Color fundus image · 45° FOV.
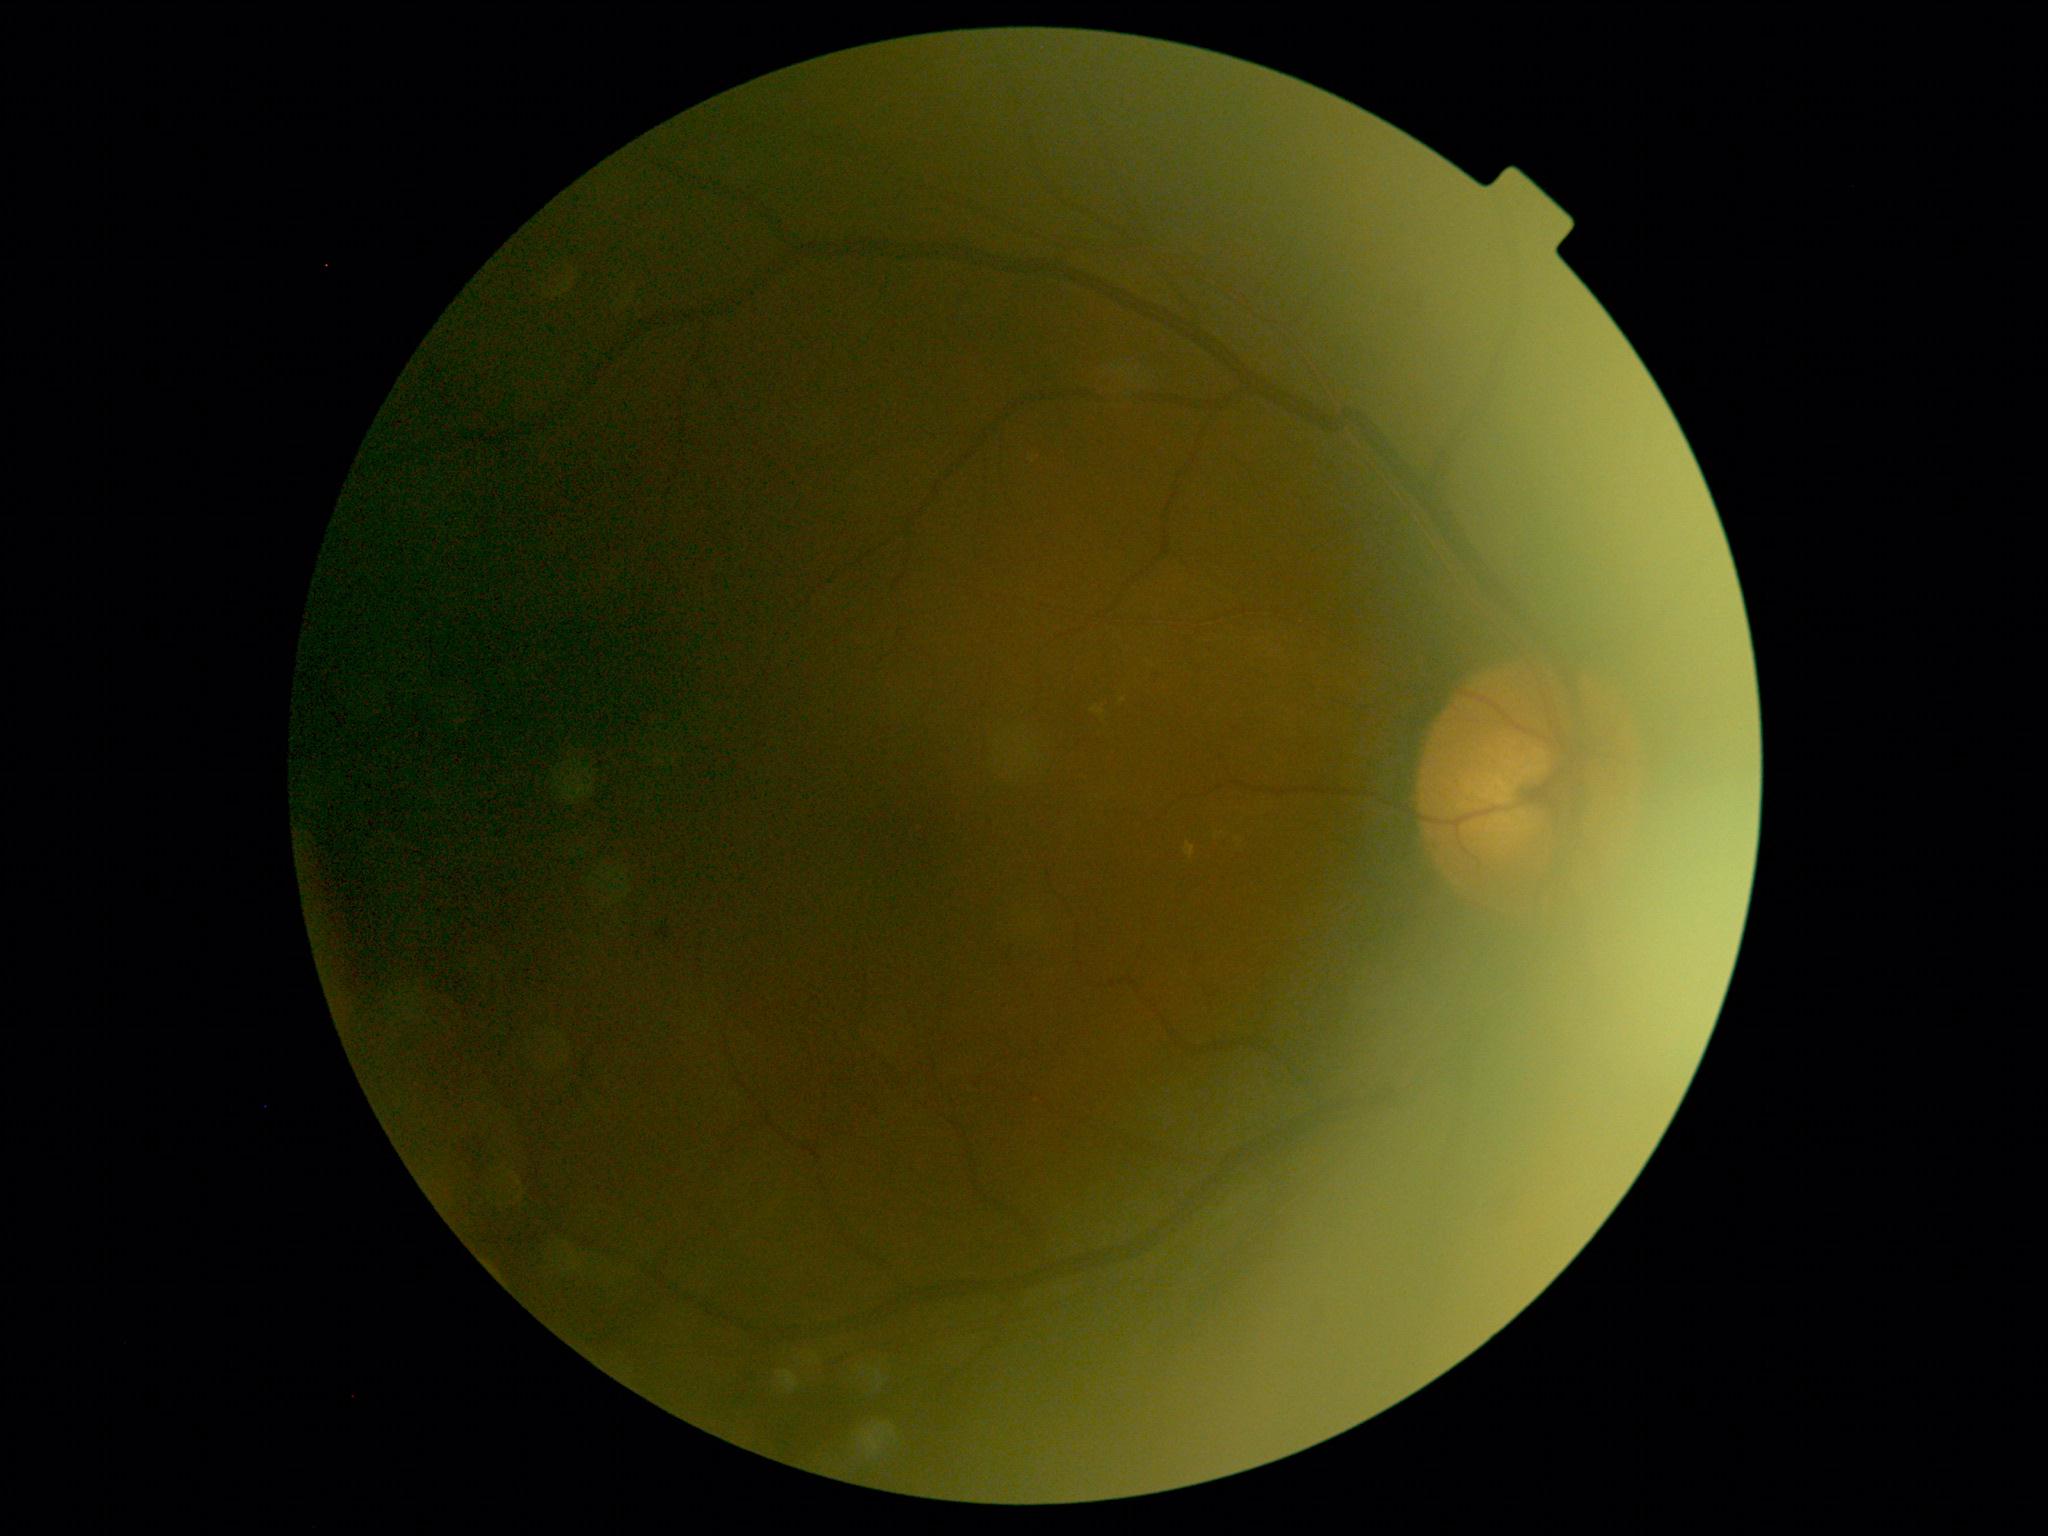

DR = moderate NPDR (grade 2).